CFP, 2352x1568, 45-degree field of view.
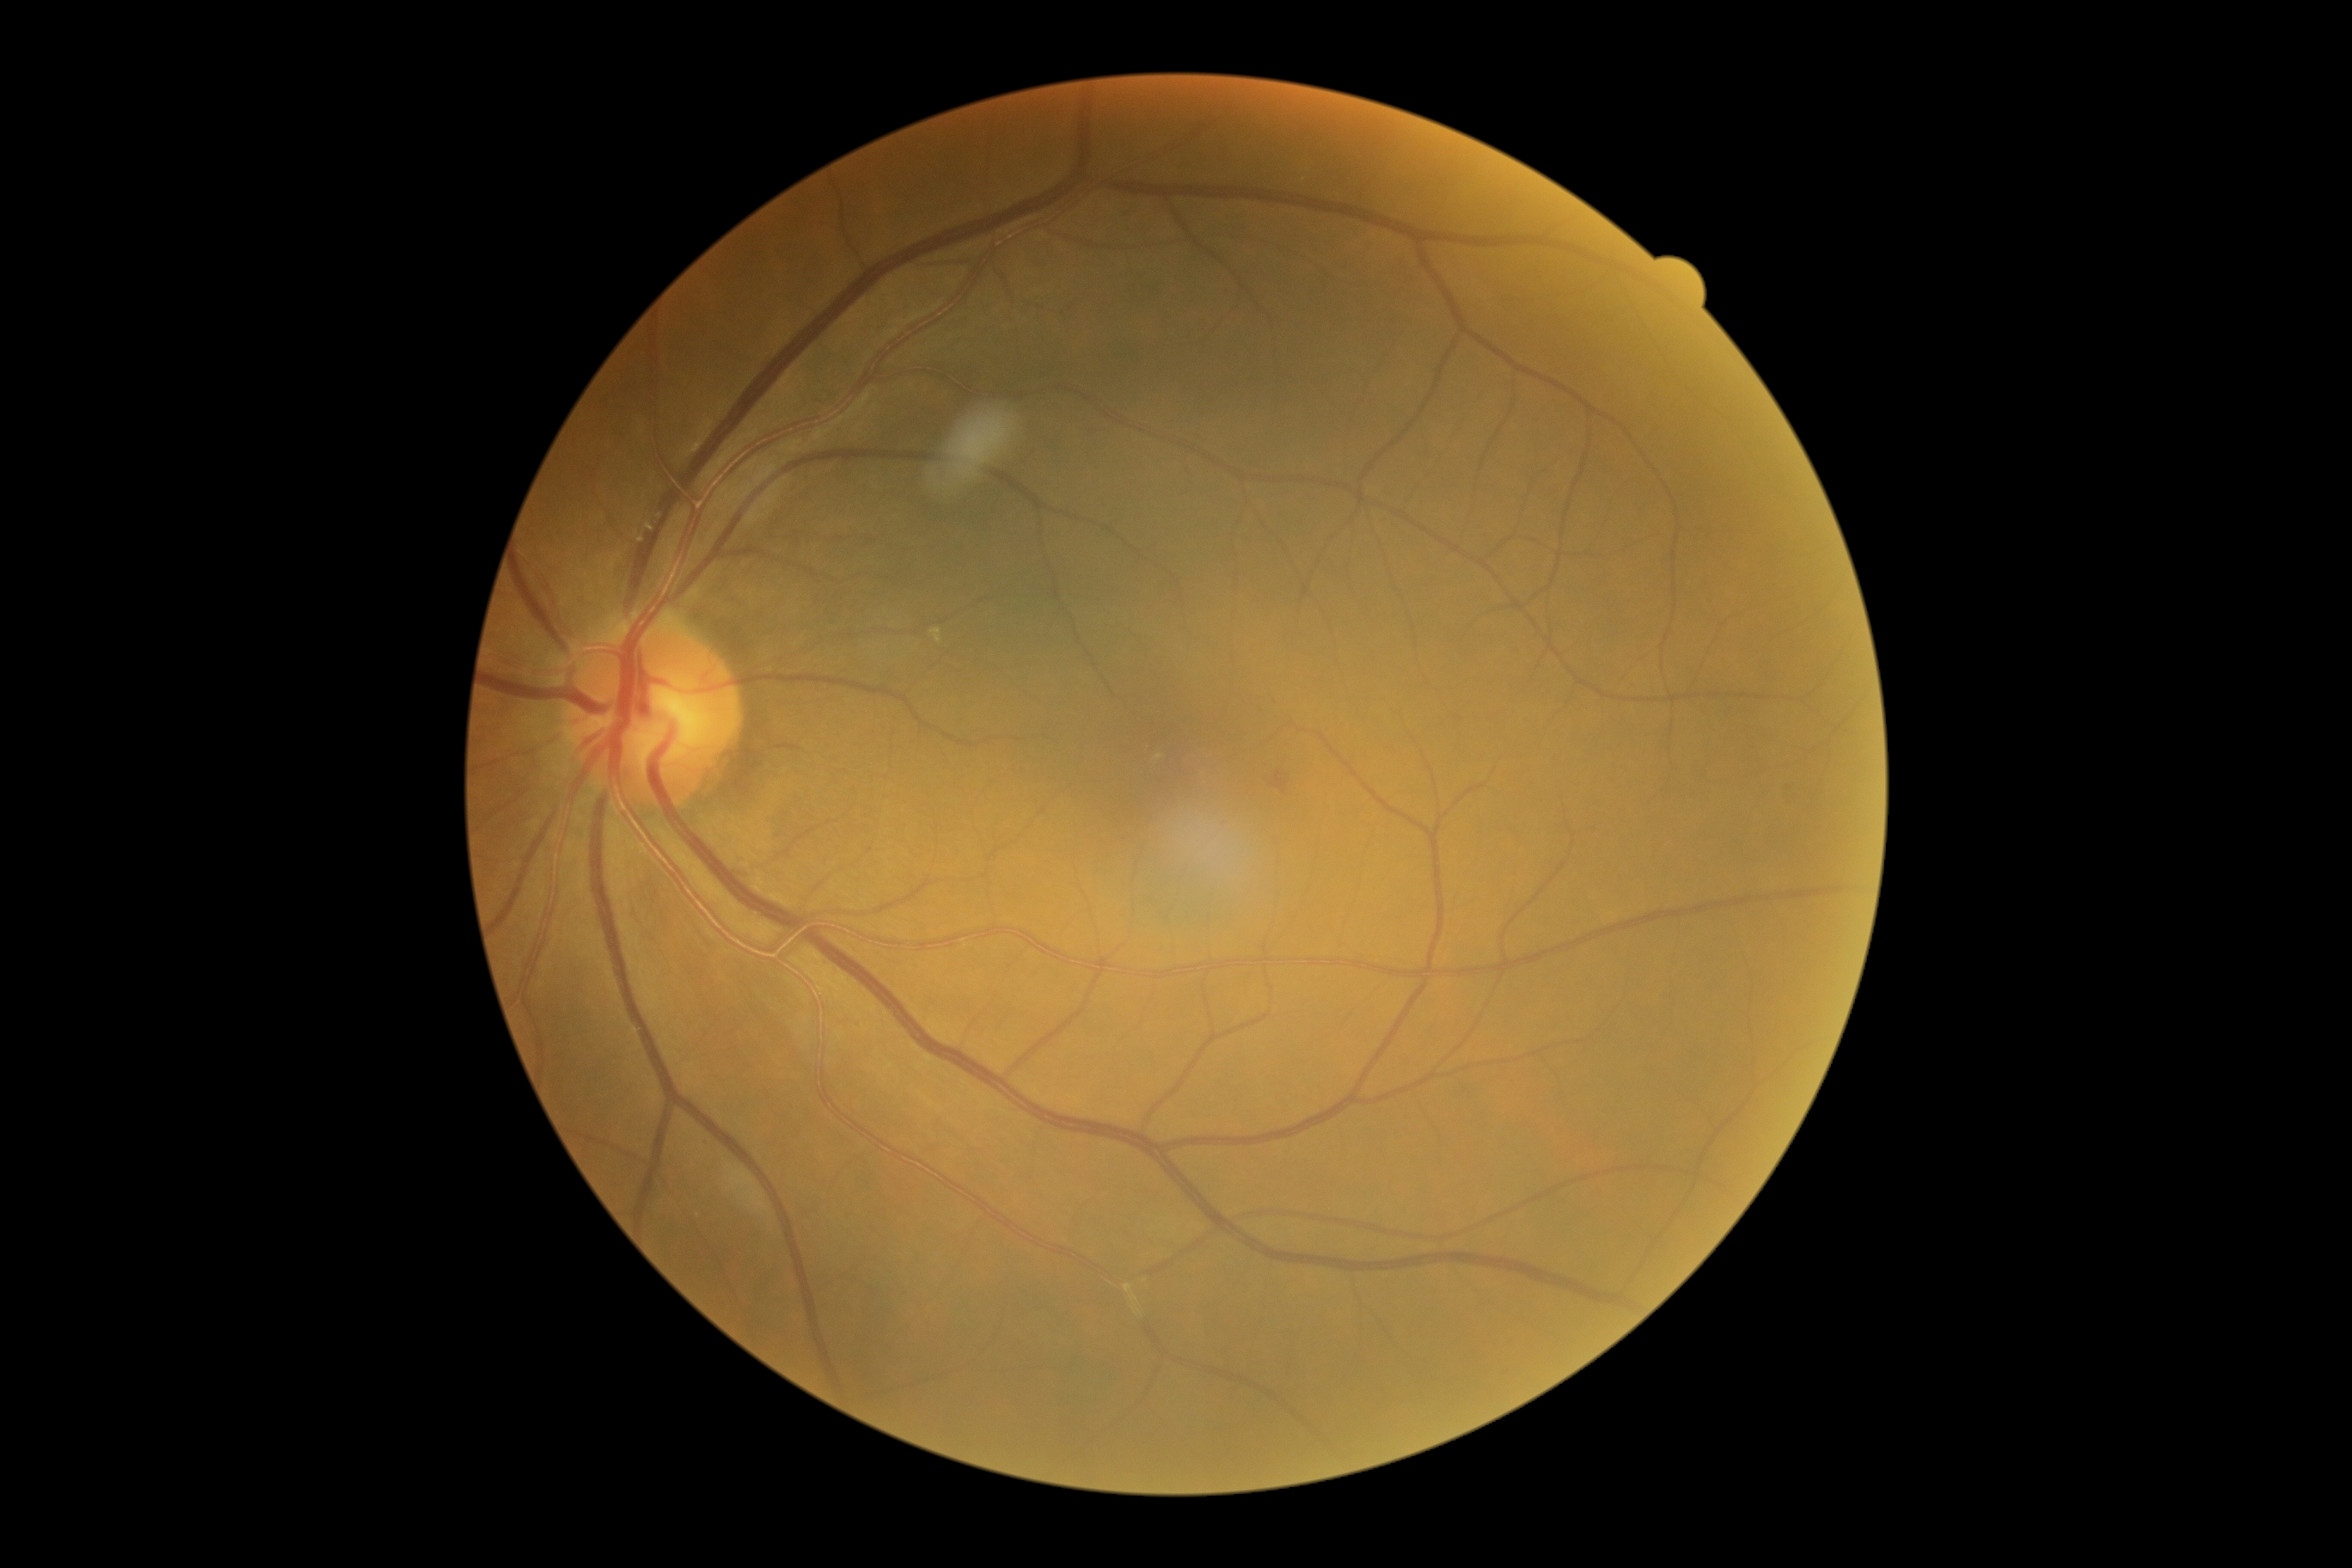

DR grade: 2 (moderate NPDR).